Wide-field fundus image from infant ROP screening; 1240x1240px; Phoenix ICON, 100° FOV — 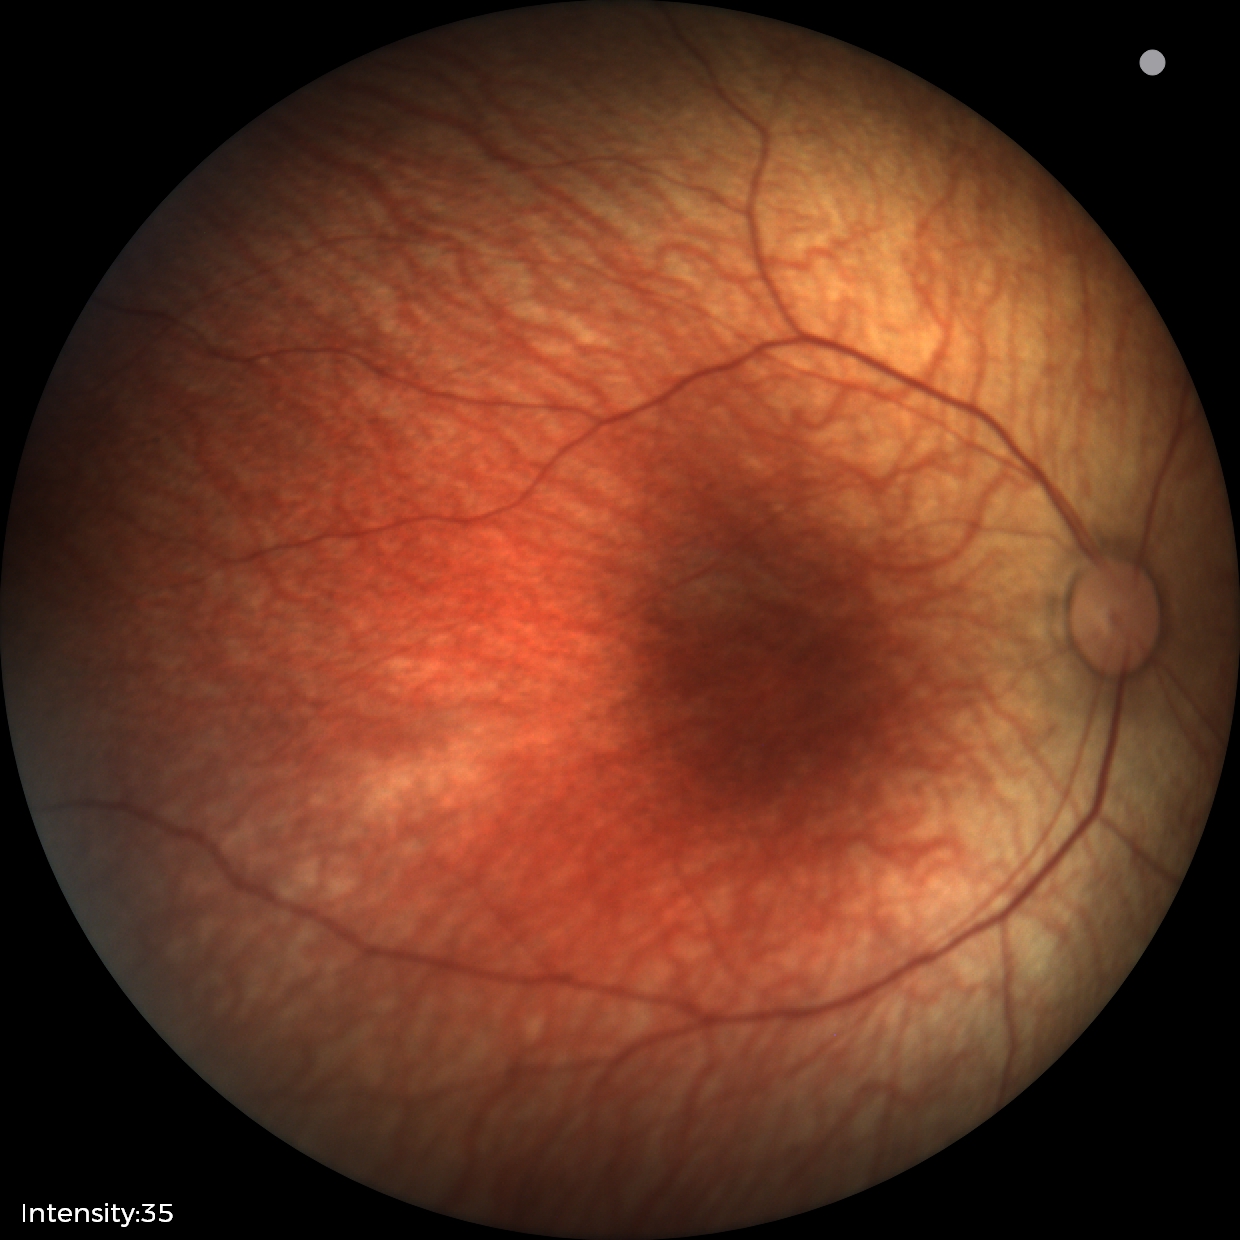
Normal screening examination.